CFP. Centered on the macula.
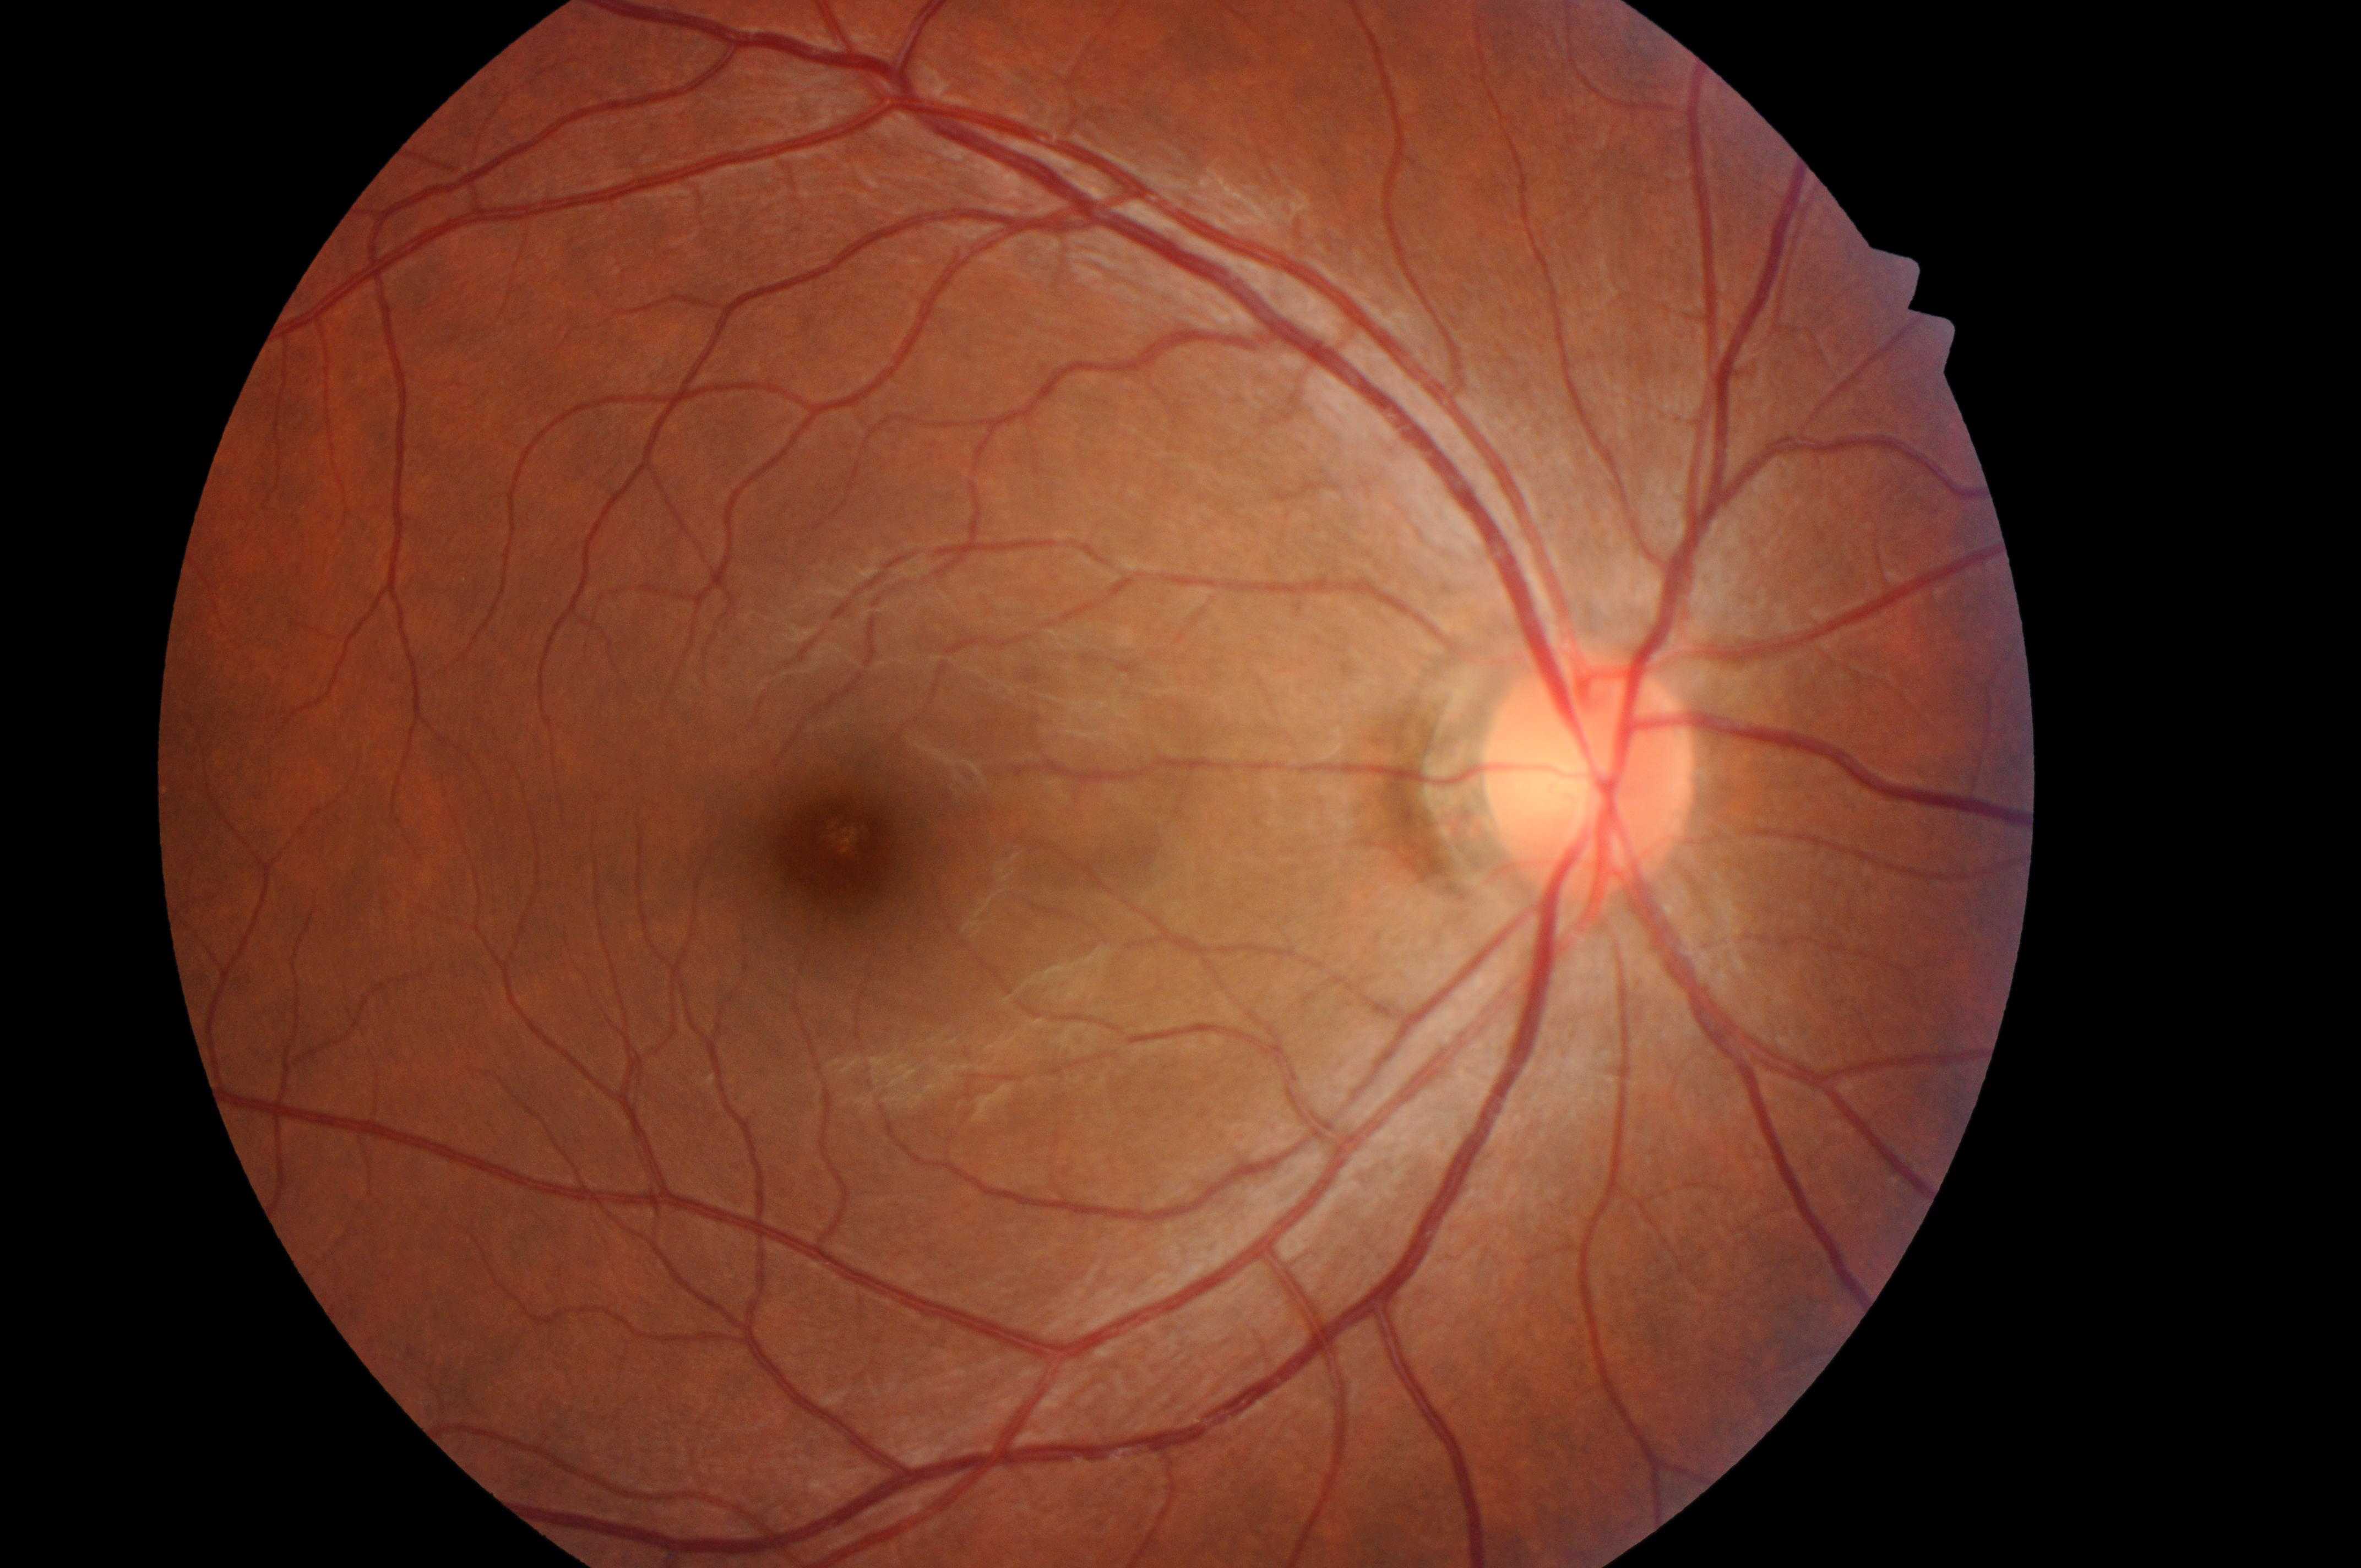
Q: Locate the fovea.
A: 837, 858
Q: What is the DME risk grade?
A: no risk (grade 0)
Q: Locate the optic disc.
A: 1586, 781
Q: Diabetic retinopathy severity?
A: grade 0 (no apparent retinopathy)
Q: Which eye is imaged?
A: right eye